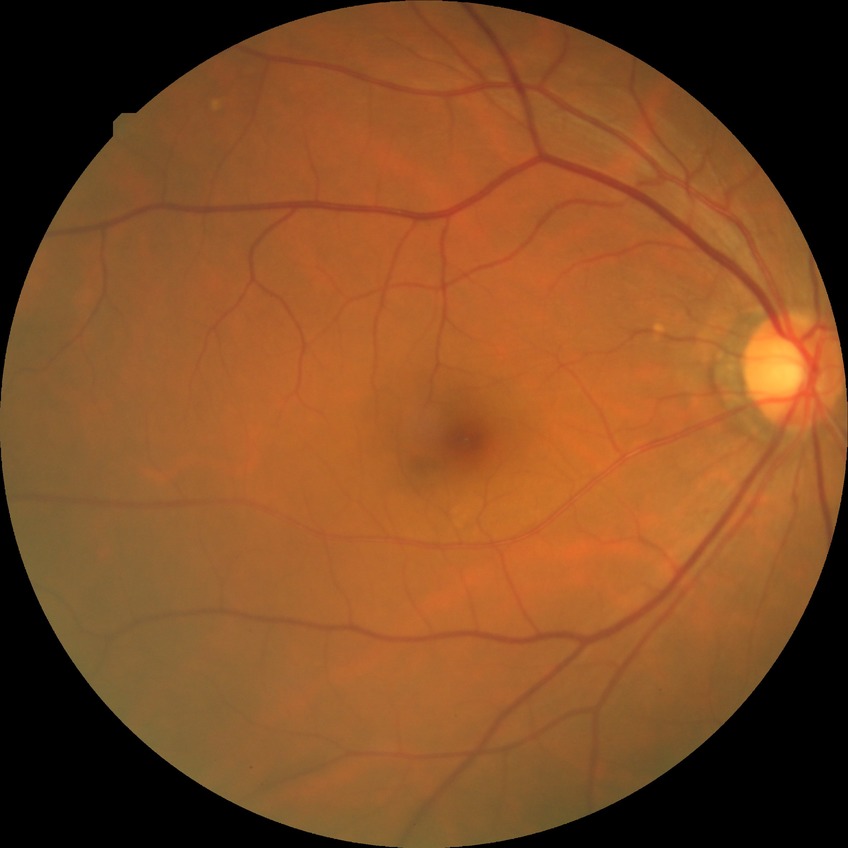 Diabetic retinopathy stage is no diabetic retinopathy.